CFP.
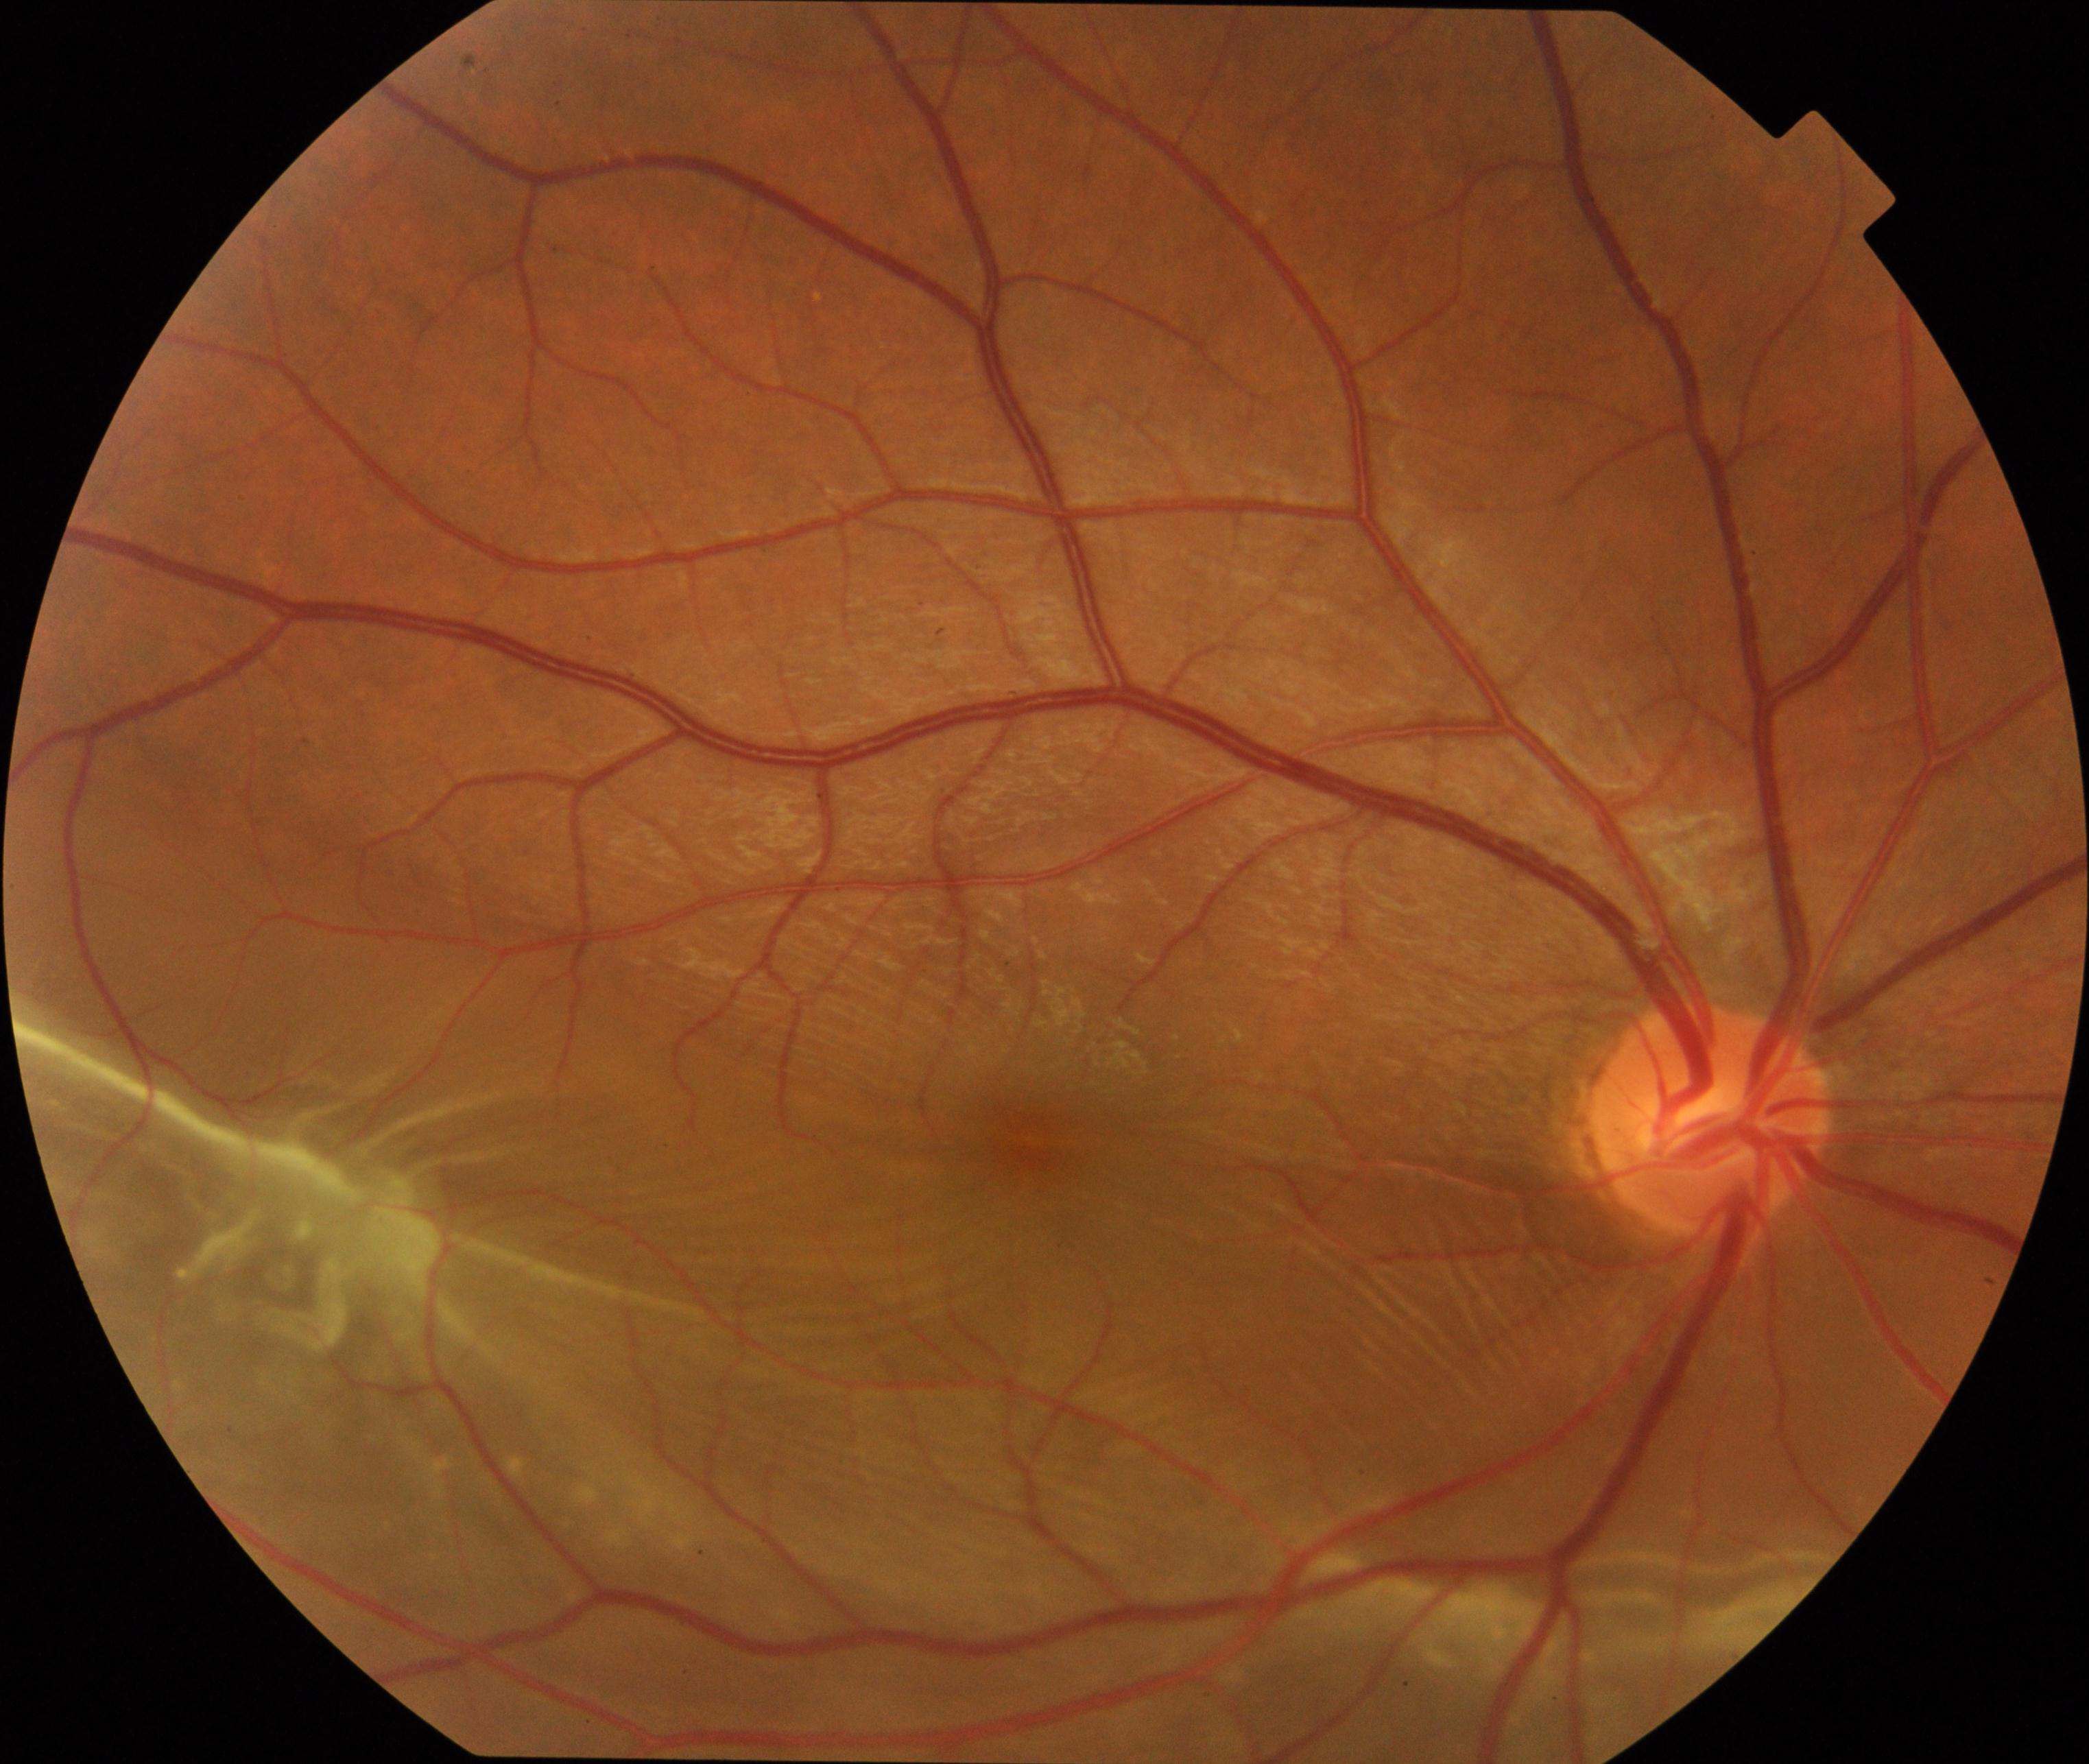 The image shows rhegmatogenous retinal detachment.